Color fundus photograph: 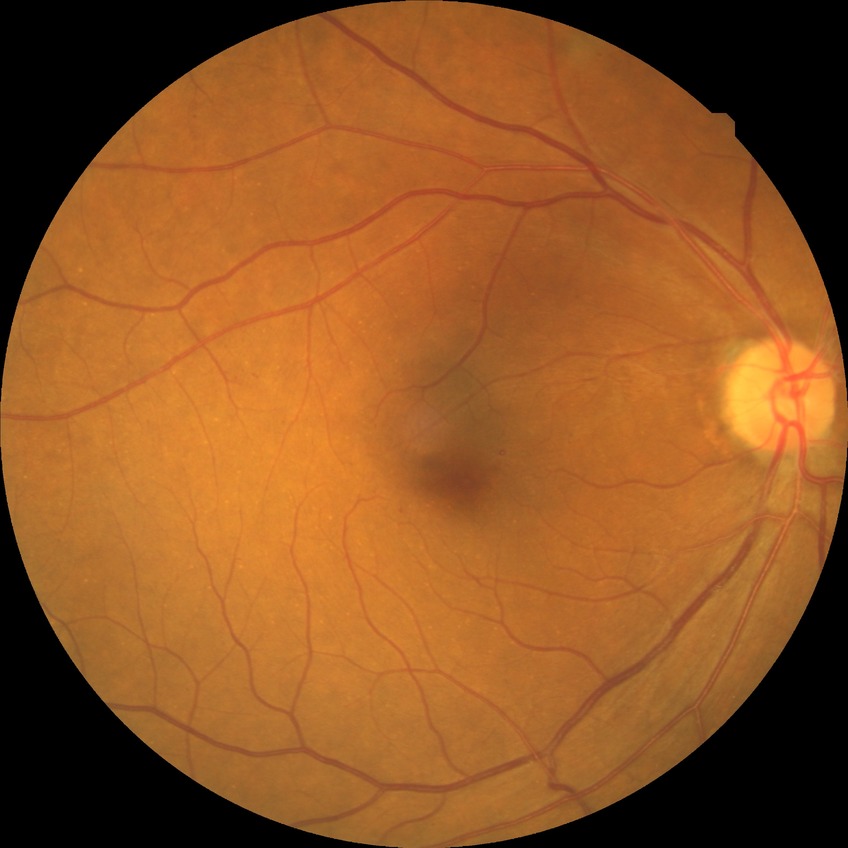
davis_grade: SDR (simple diabetic retinopathy)